NIDEK AFC-230; color fundus image; 848 by 848 pixels; no pharmacologic dilation
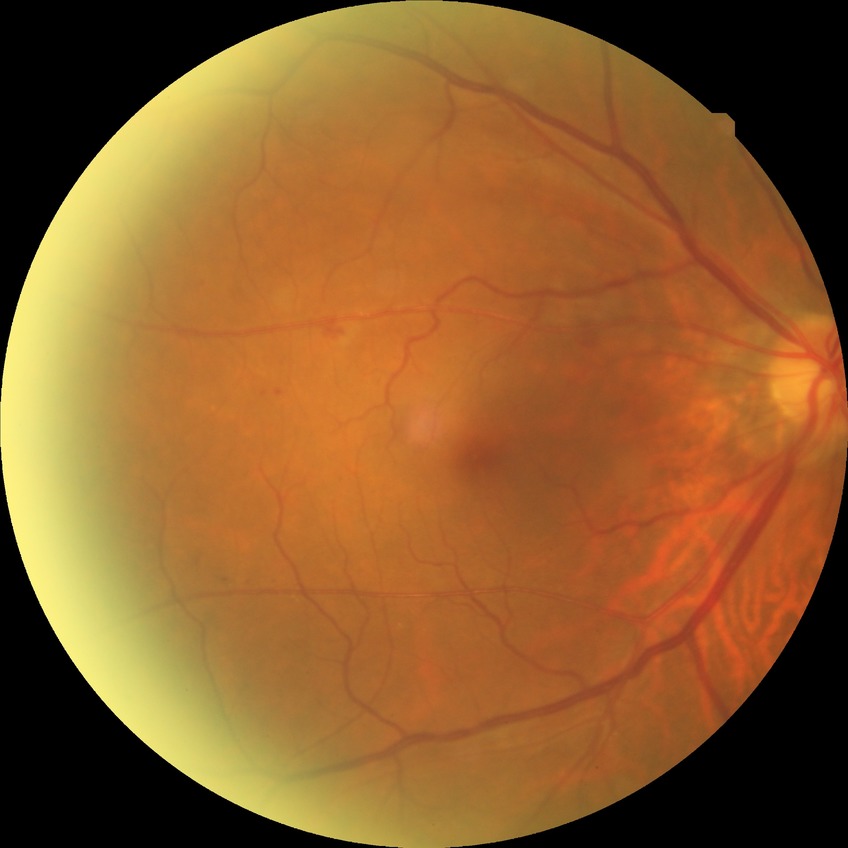

DR stage@SDR.